Disc-centered field — 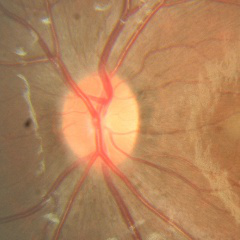

Q: What is the glaucoma diagnosis?
A: No glaucomatous findings.